1932x1910px:
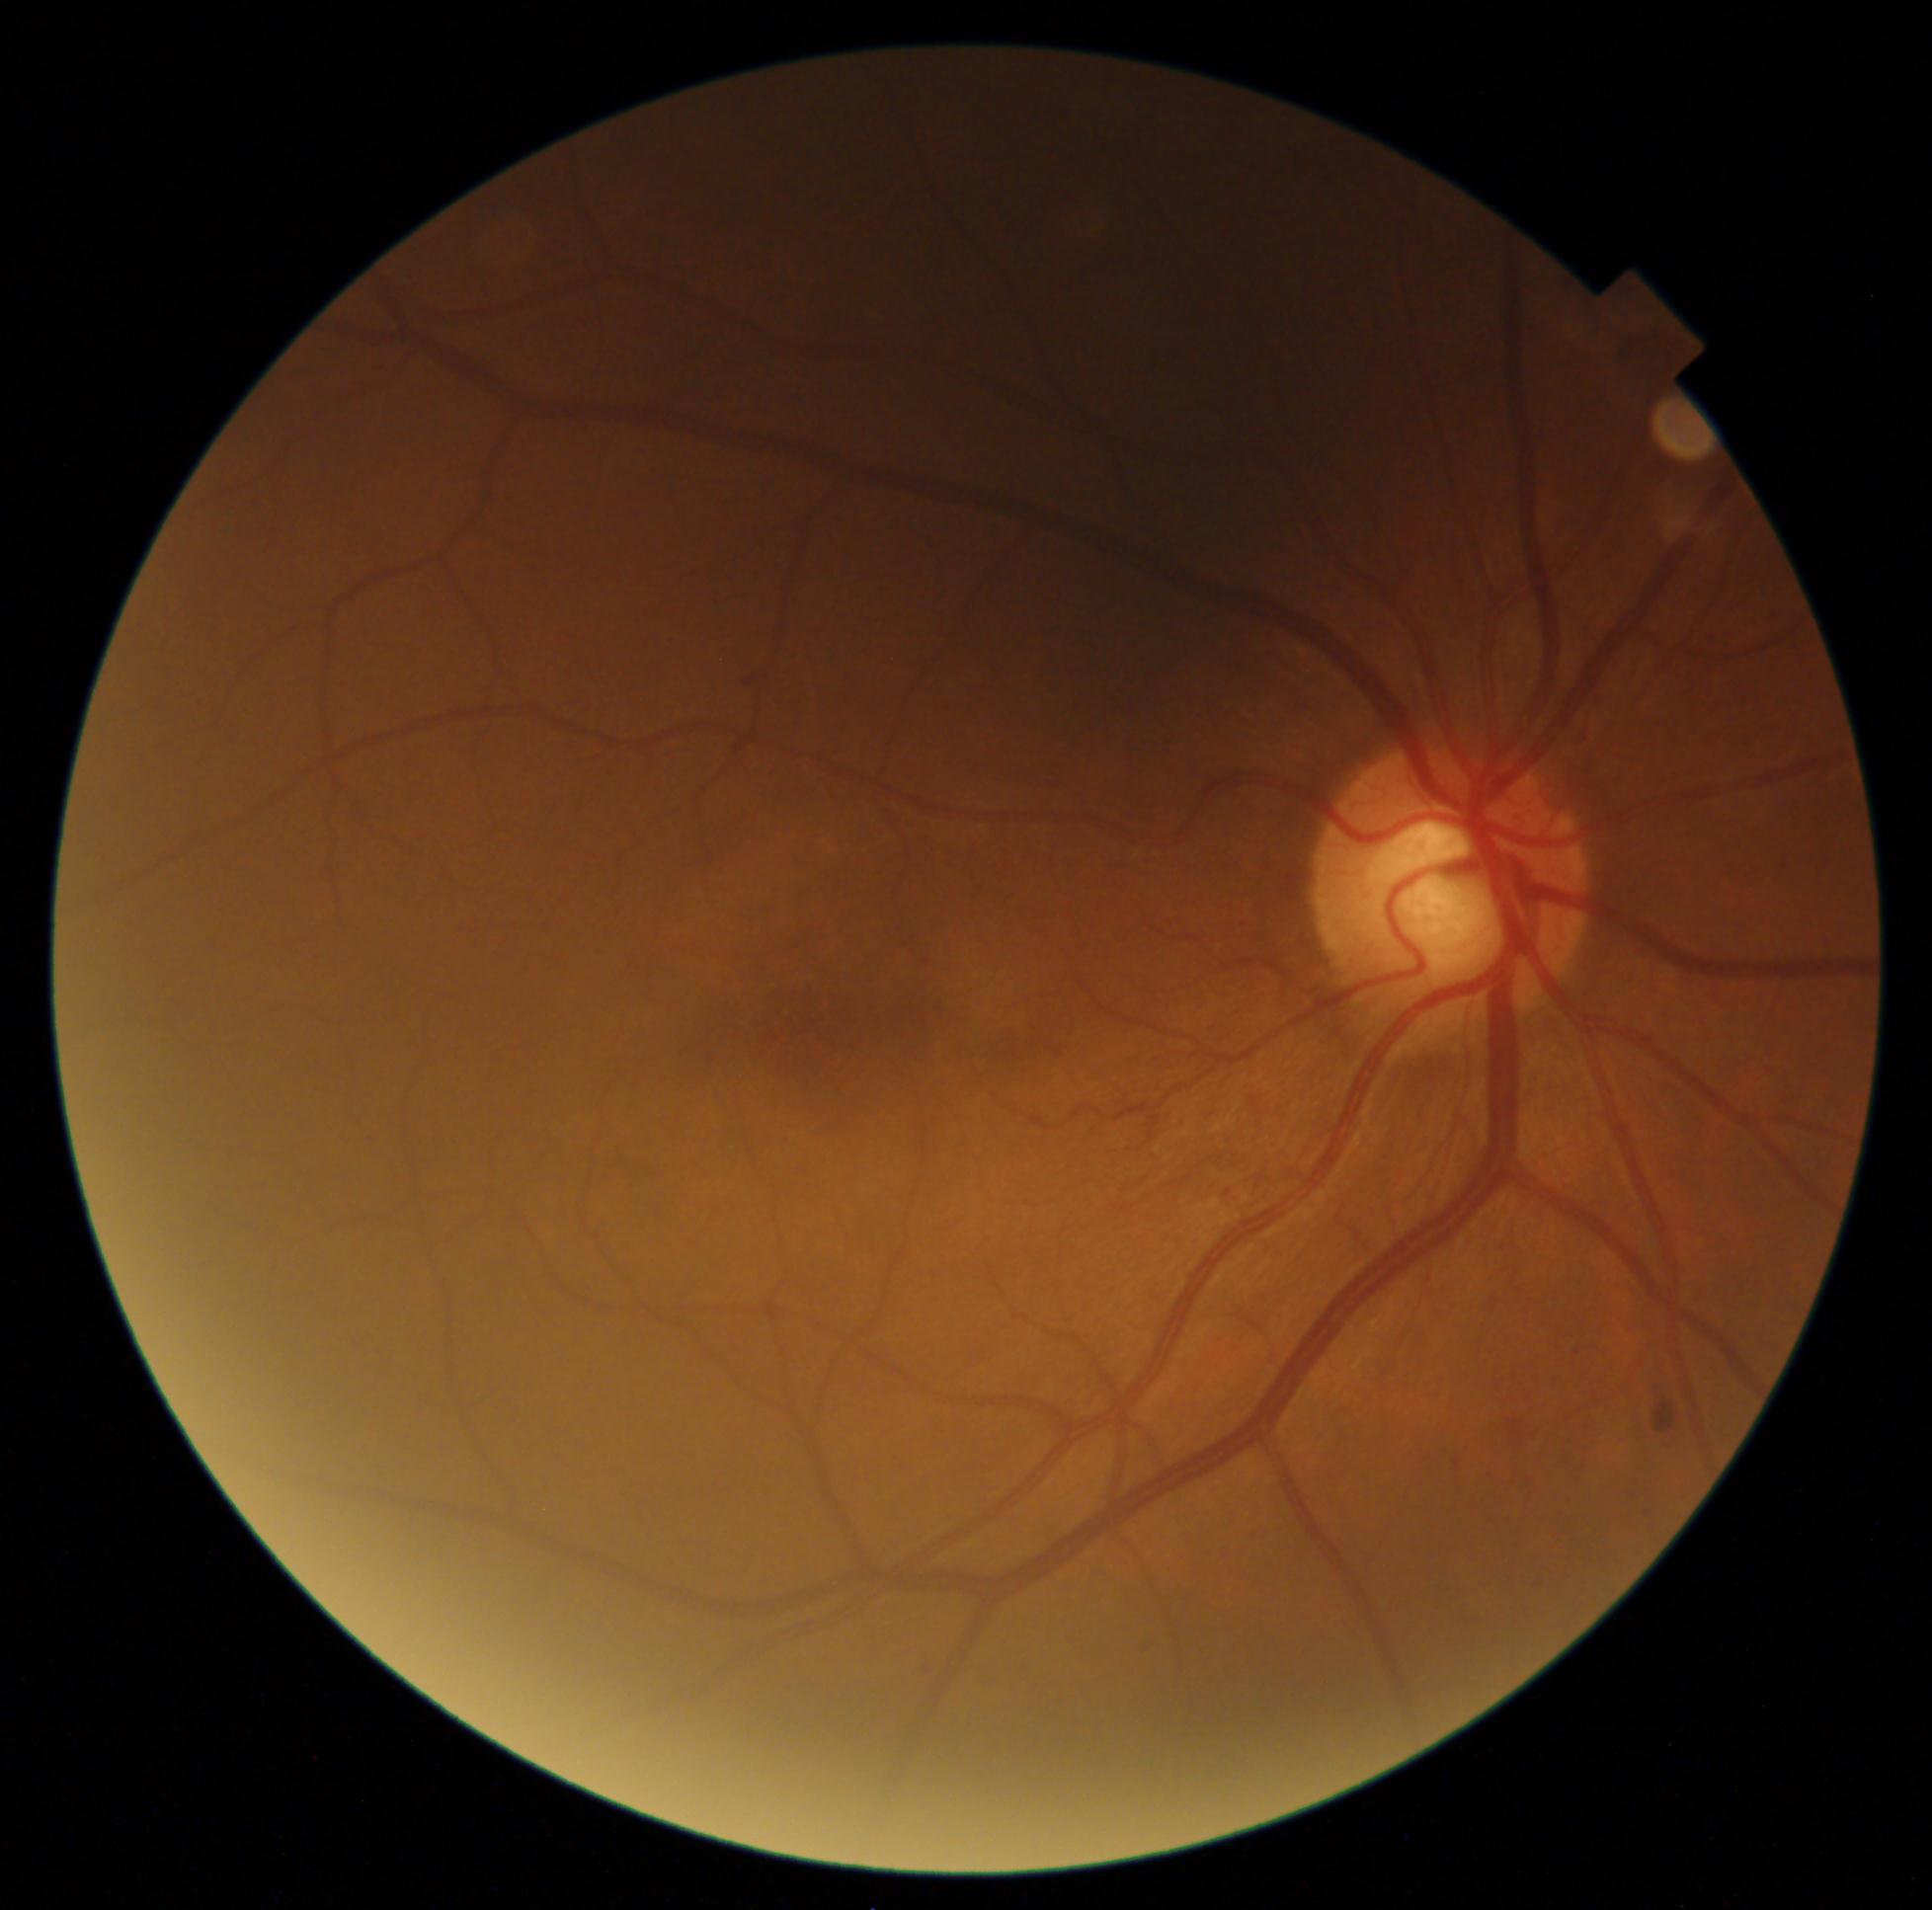 DR stage@moderate NPDR (grade 2) — more than just microaneurysms but less than severe NPDR.